Retinal fundus photograph
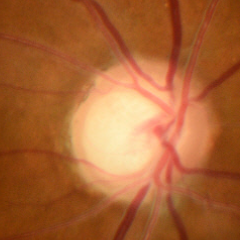 Findings consistent with glaucoma. The image shows early glaucomatous optic neuropathy. (Criteria: glaucomatous retinal nerve fiber layer defects on red-free fundus photography without visual field defects.)